697 x 697 pixels, camera: Topcon TRC, ONH-centered crop from a color fundus image: 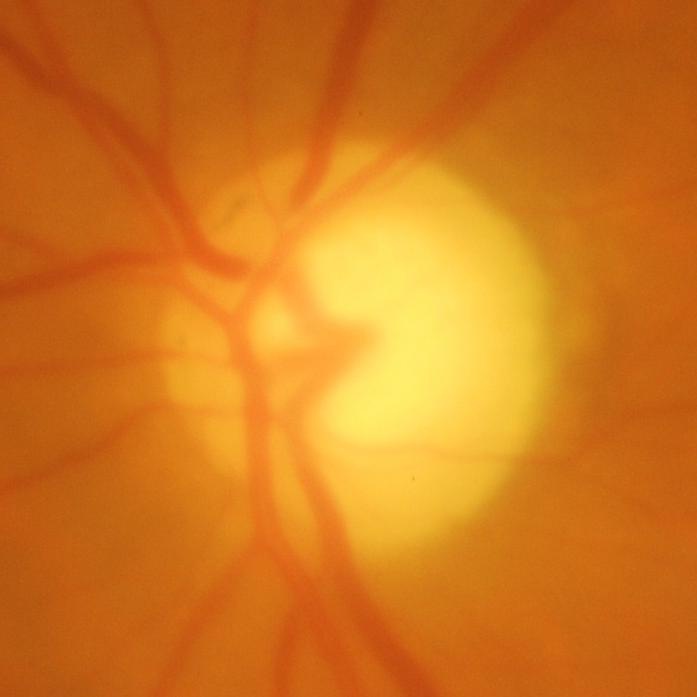 Finding = glaucoma.